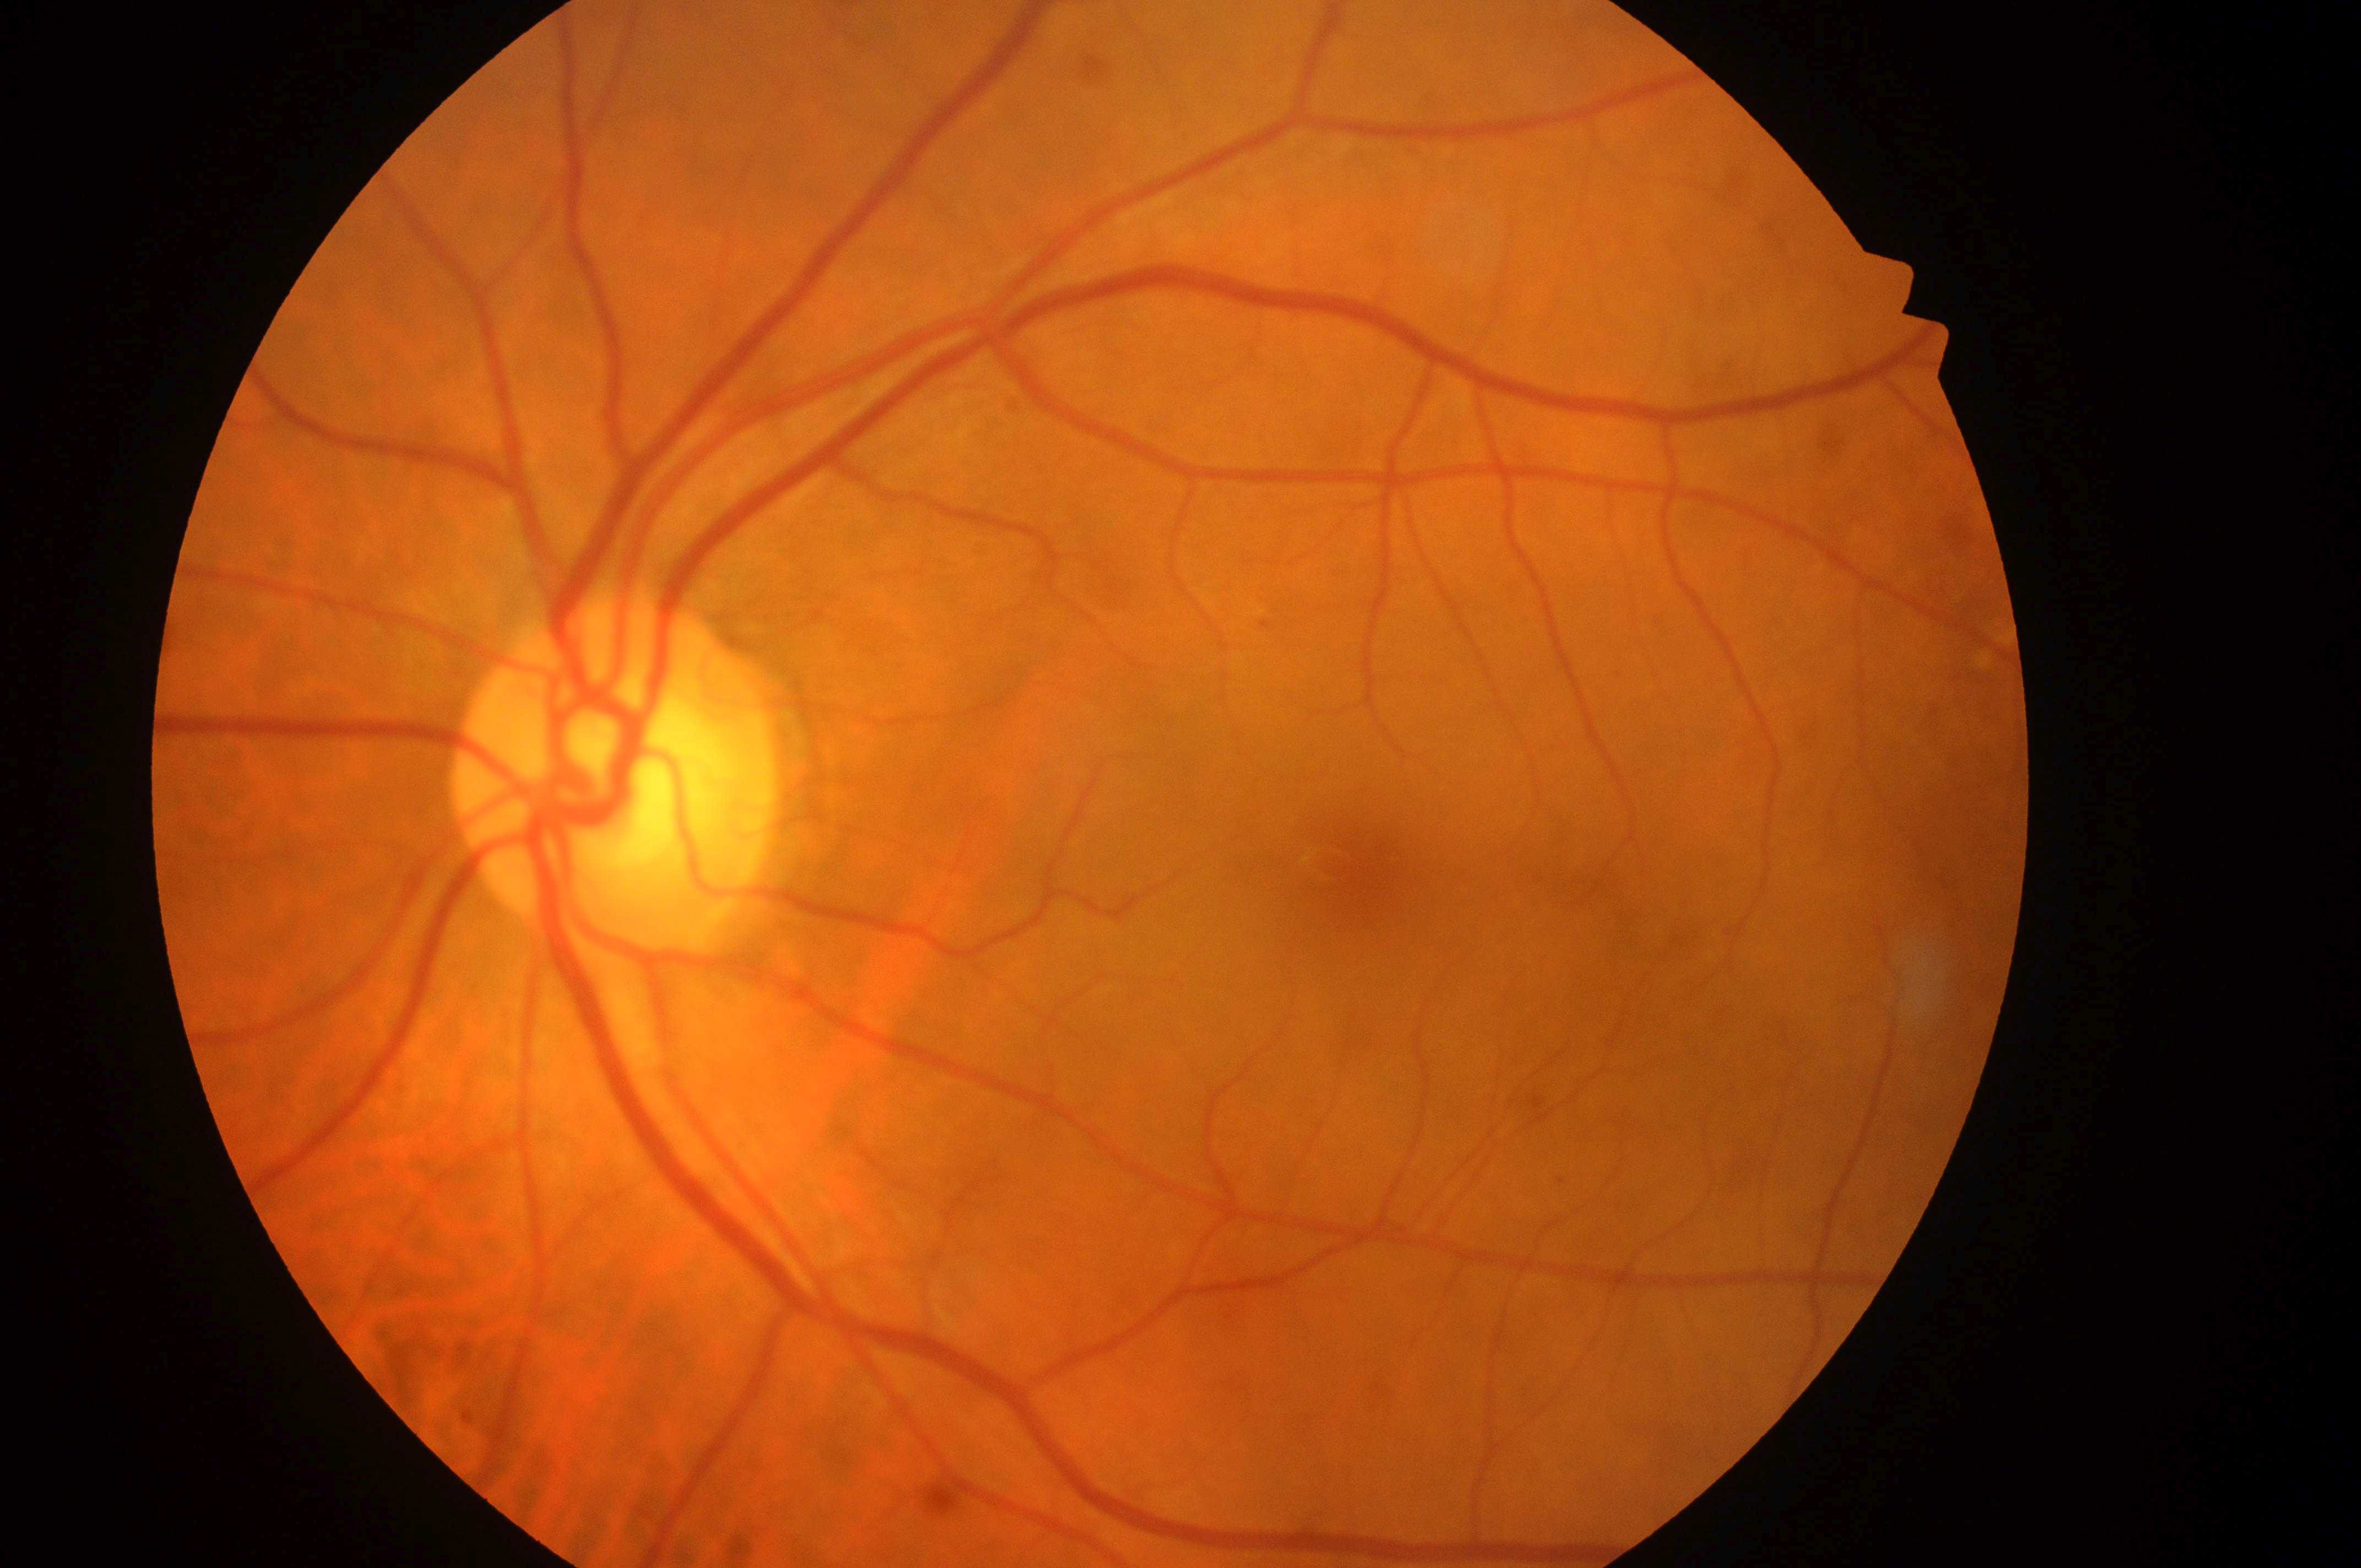
Fovea center located at x=1368, y=883.
DR stage: moderate NPDR (grade 2).
The disc center is at x=610, y=792.
Imaged eye: left eye.
Disease class: non-proliferative diabetic retinopathy.
DME grade: low risk (1).